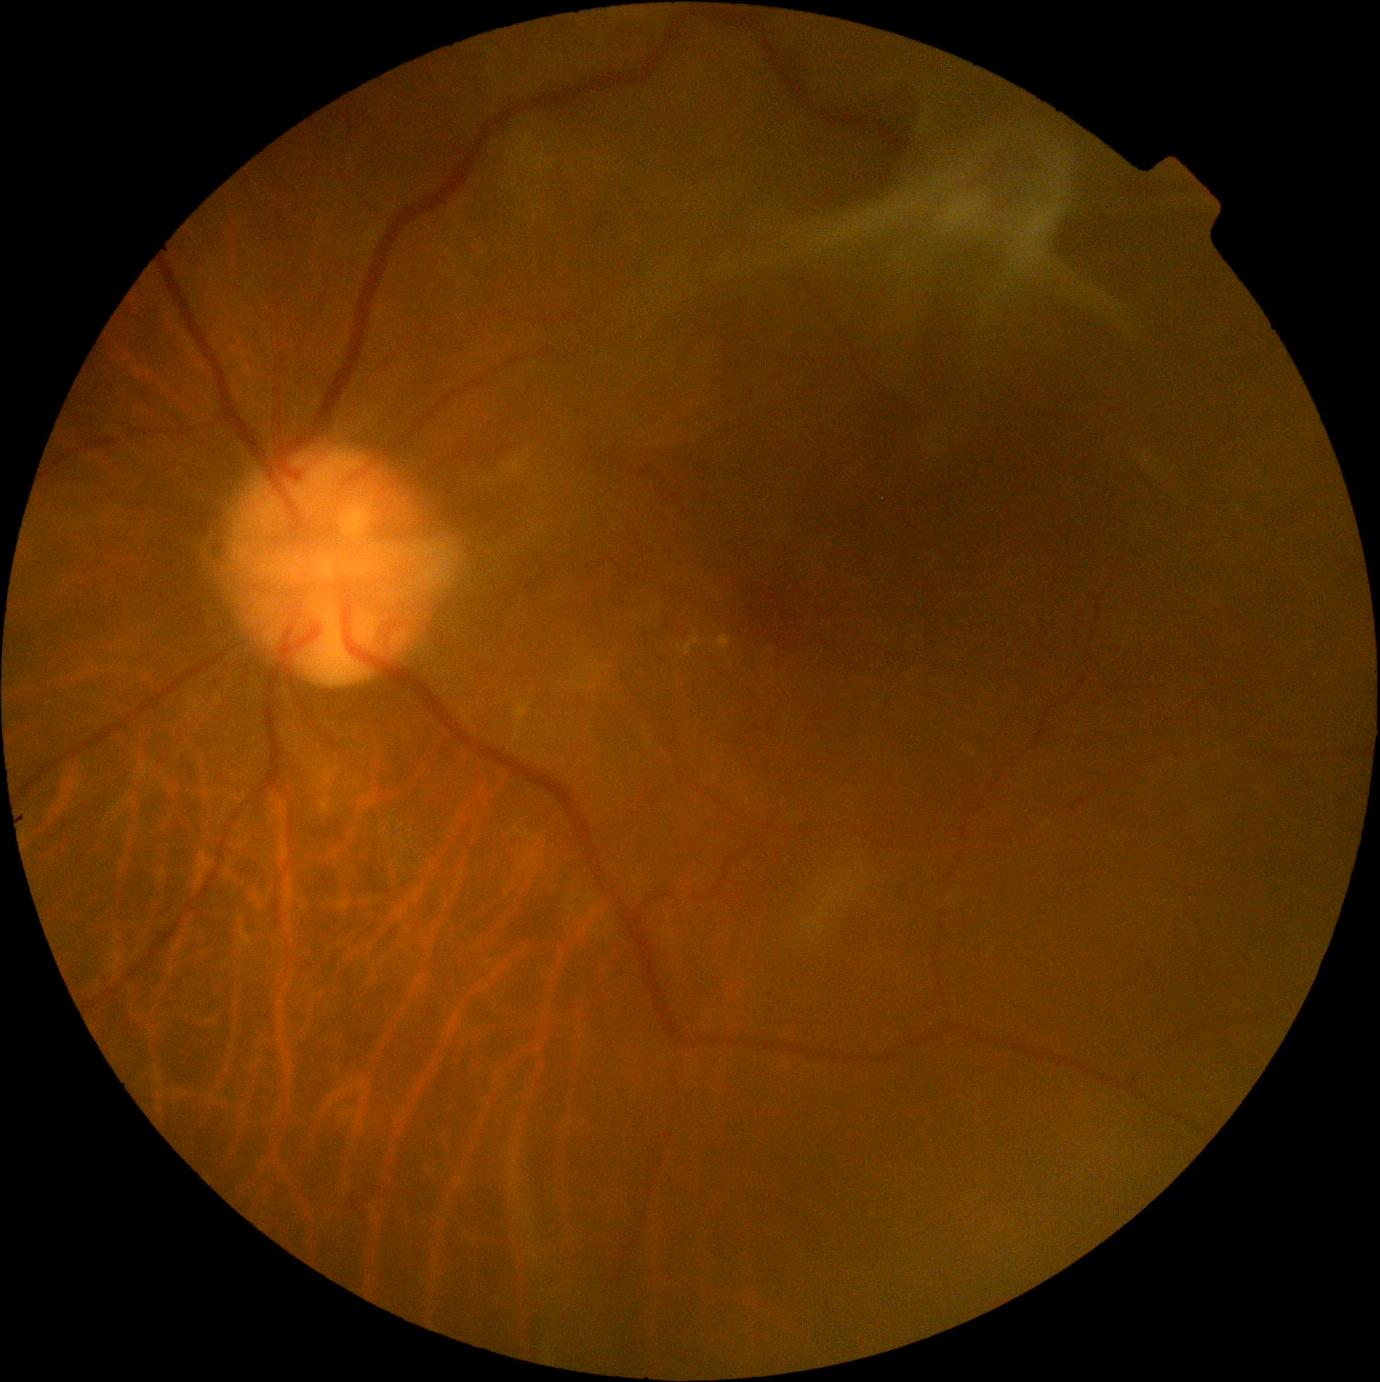

DR grade is proliferative diabetic retinopathy (4).
Disease class: proliferative diabetic retinopathy.